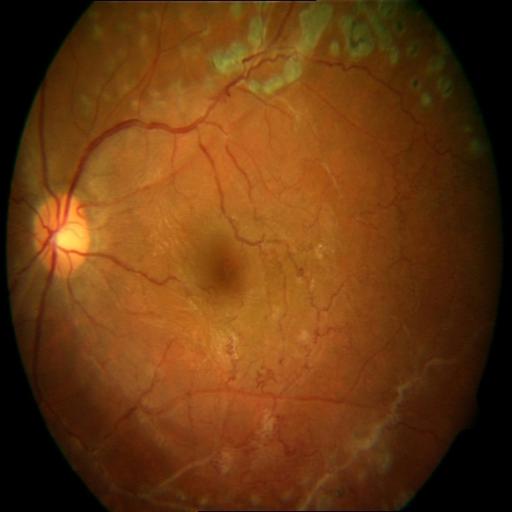 Pathology: laser scars.